2048 x 1536 pixels.
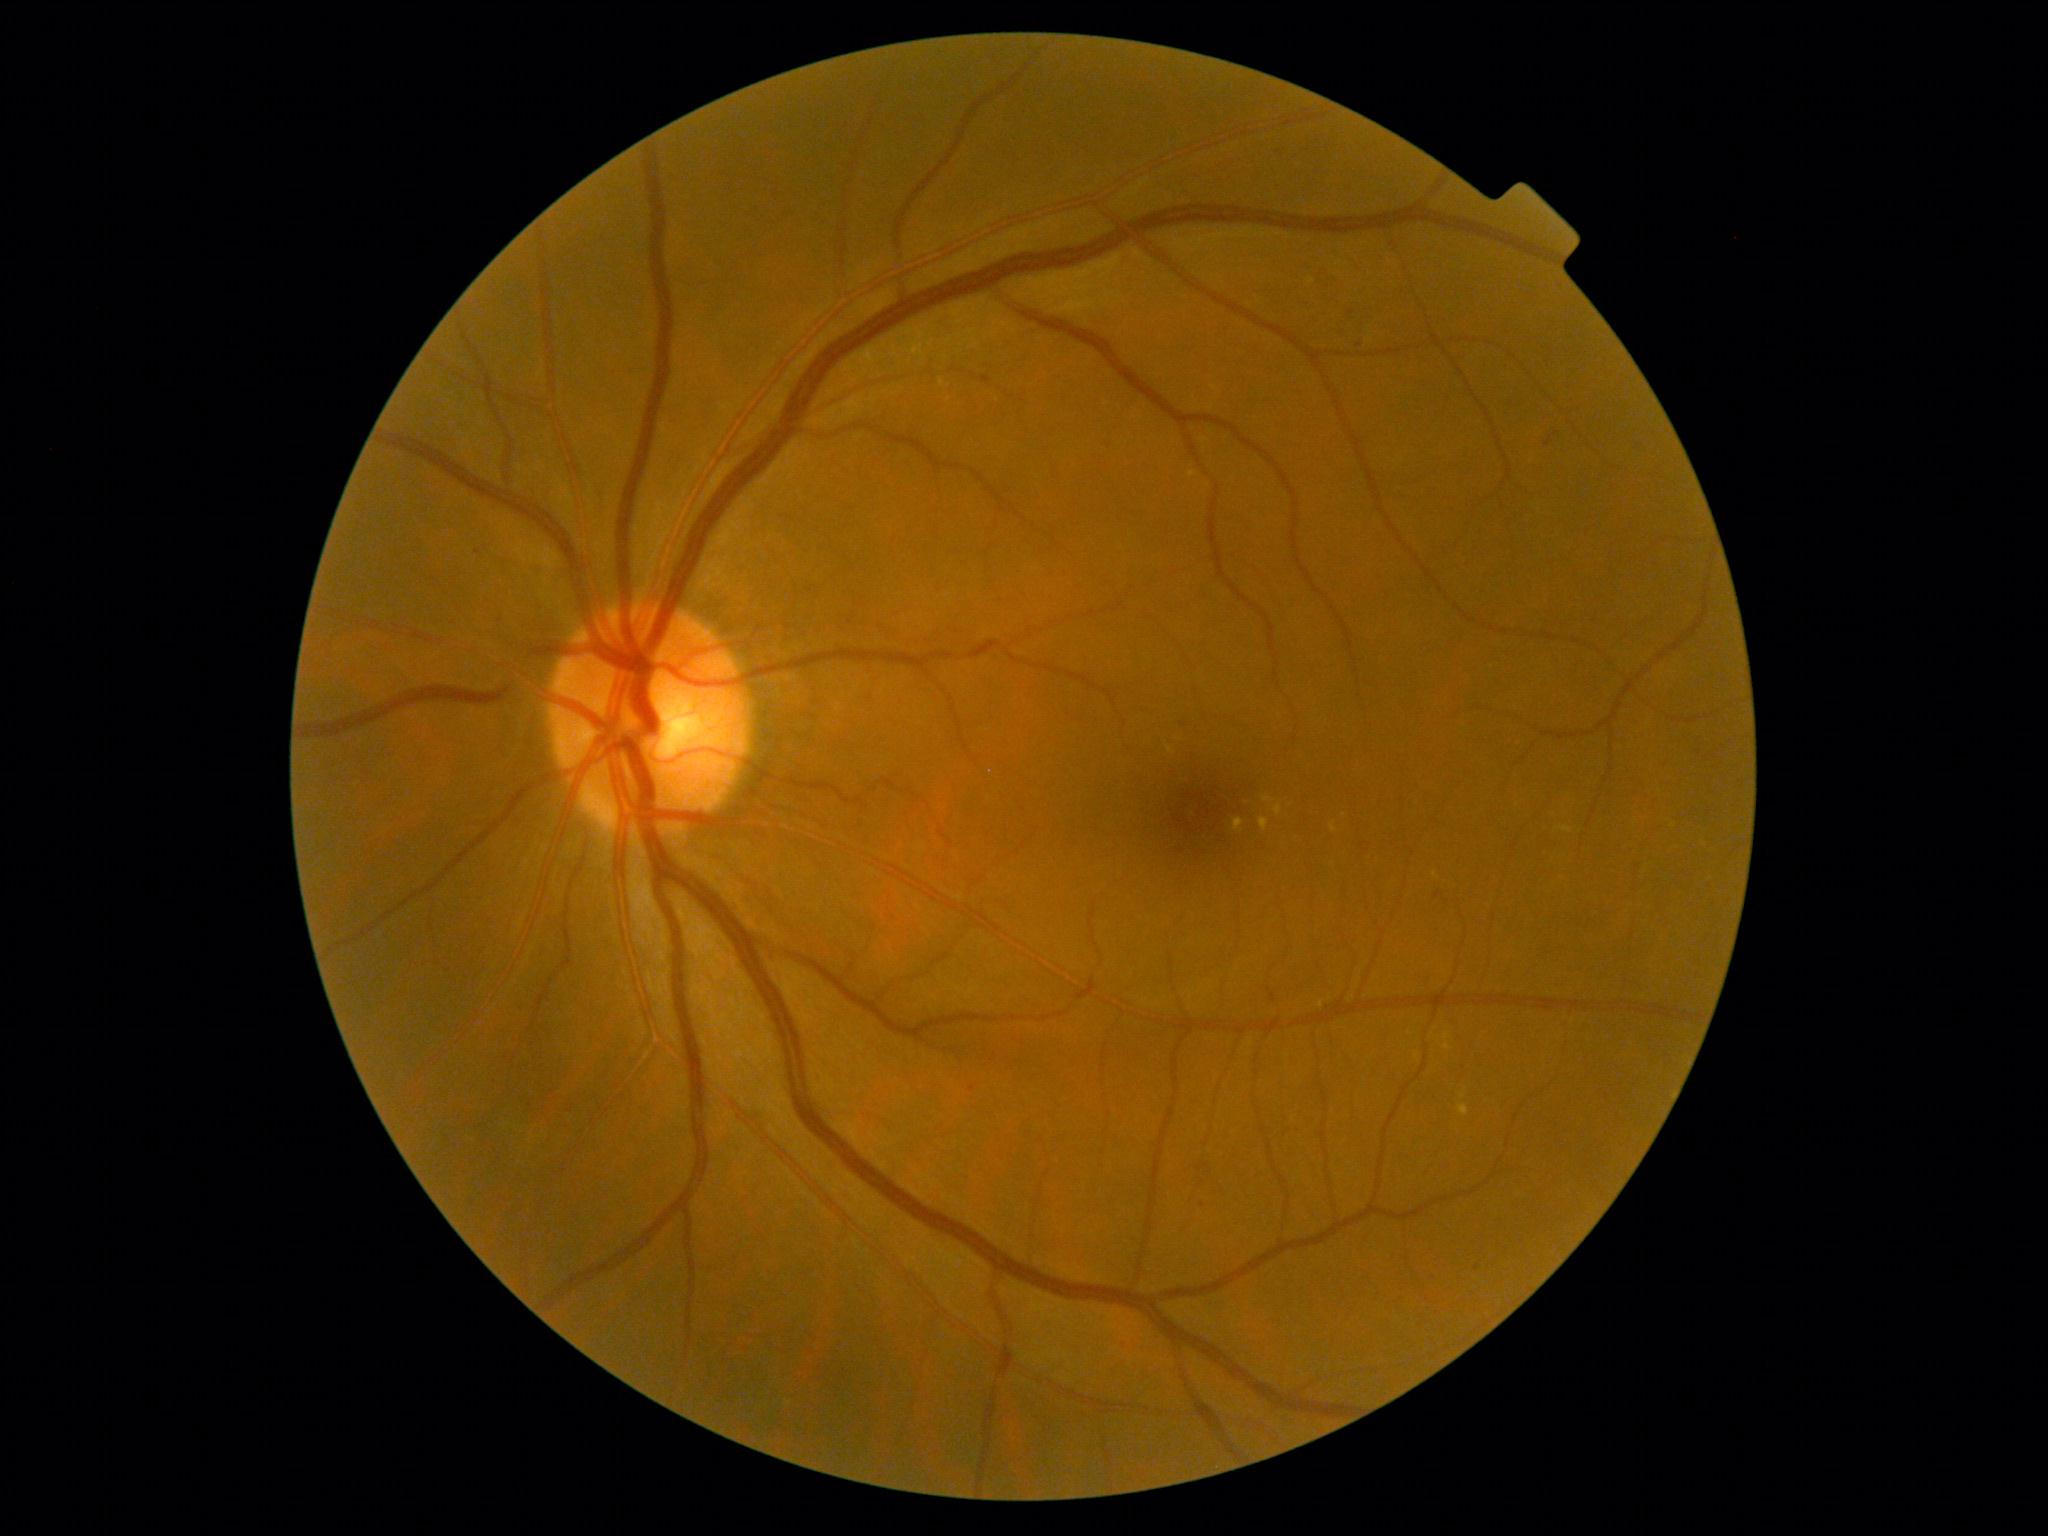 Findings:
– DR stage — grade 2 (moderate NPDR) — more than just microaneurysms but less than severe NPDR
– DR class — non-proliferative diabetic retinopathy